45 degree fundus photograph. NIDEK AFC-230: 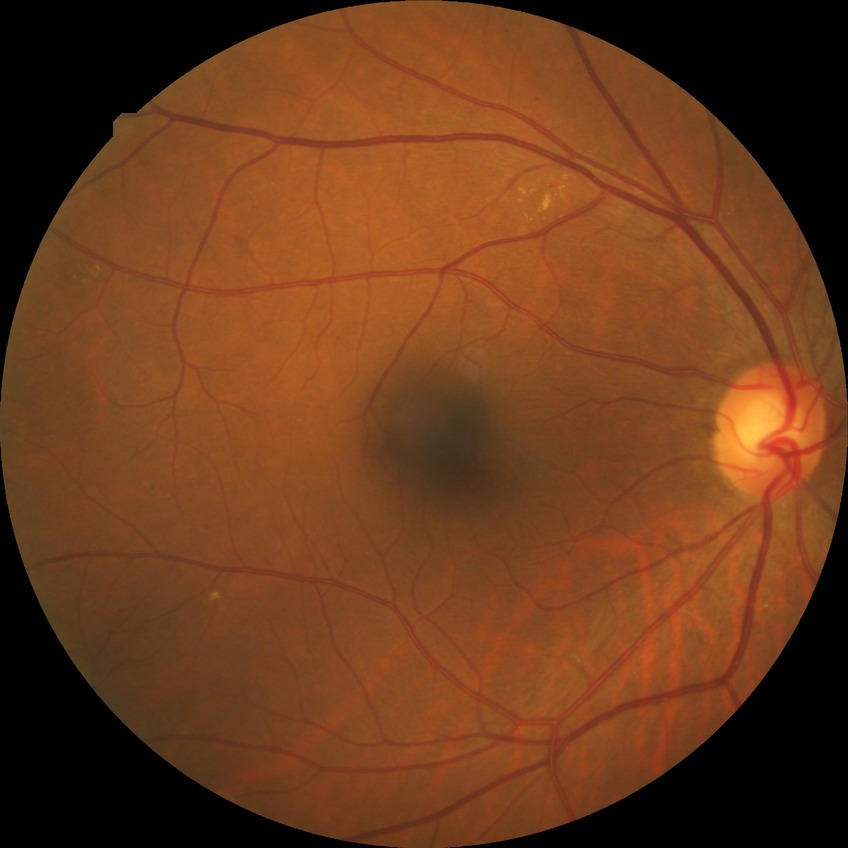
Diabetic retinopathy (DR) is SDR (simple diabetic retinopathy).